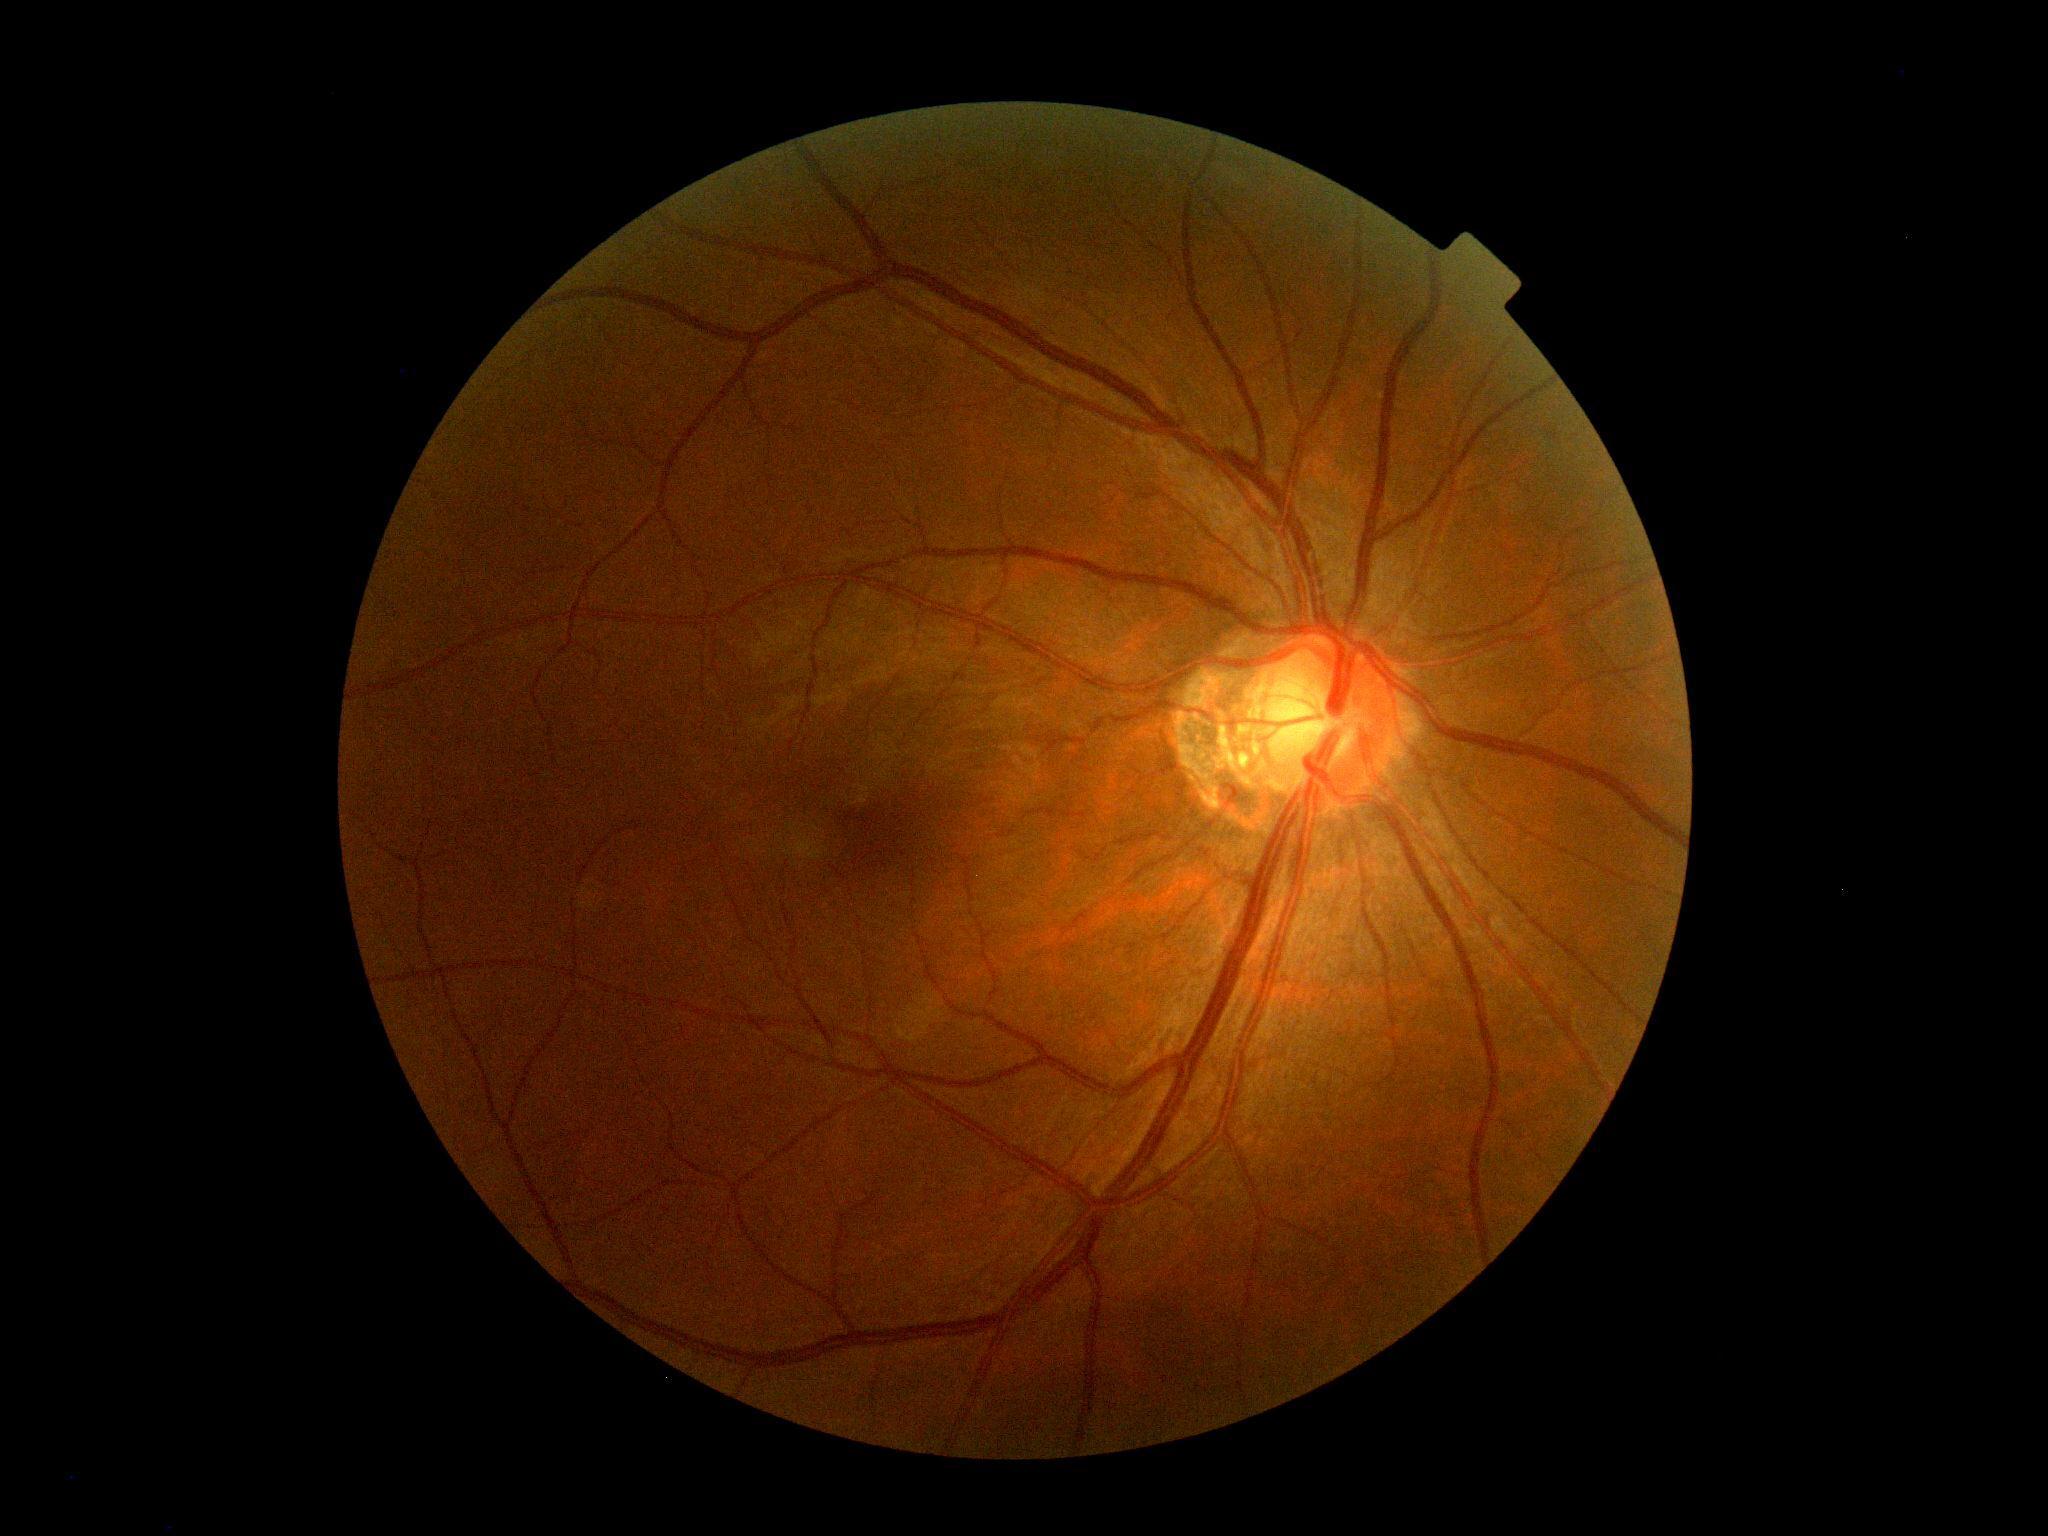 DR severity is 0.